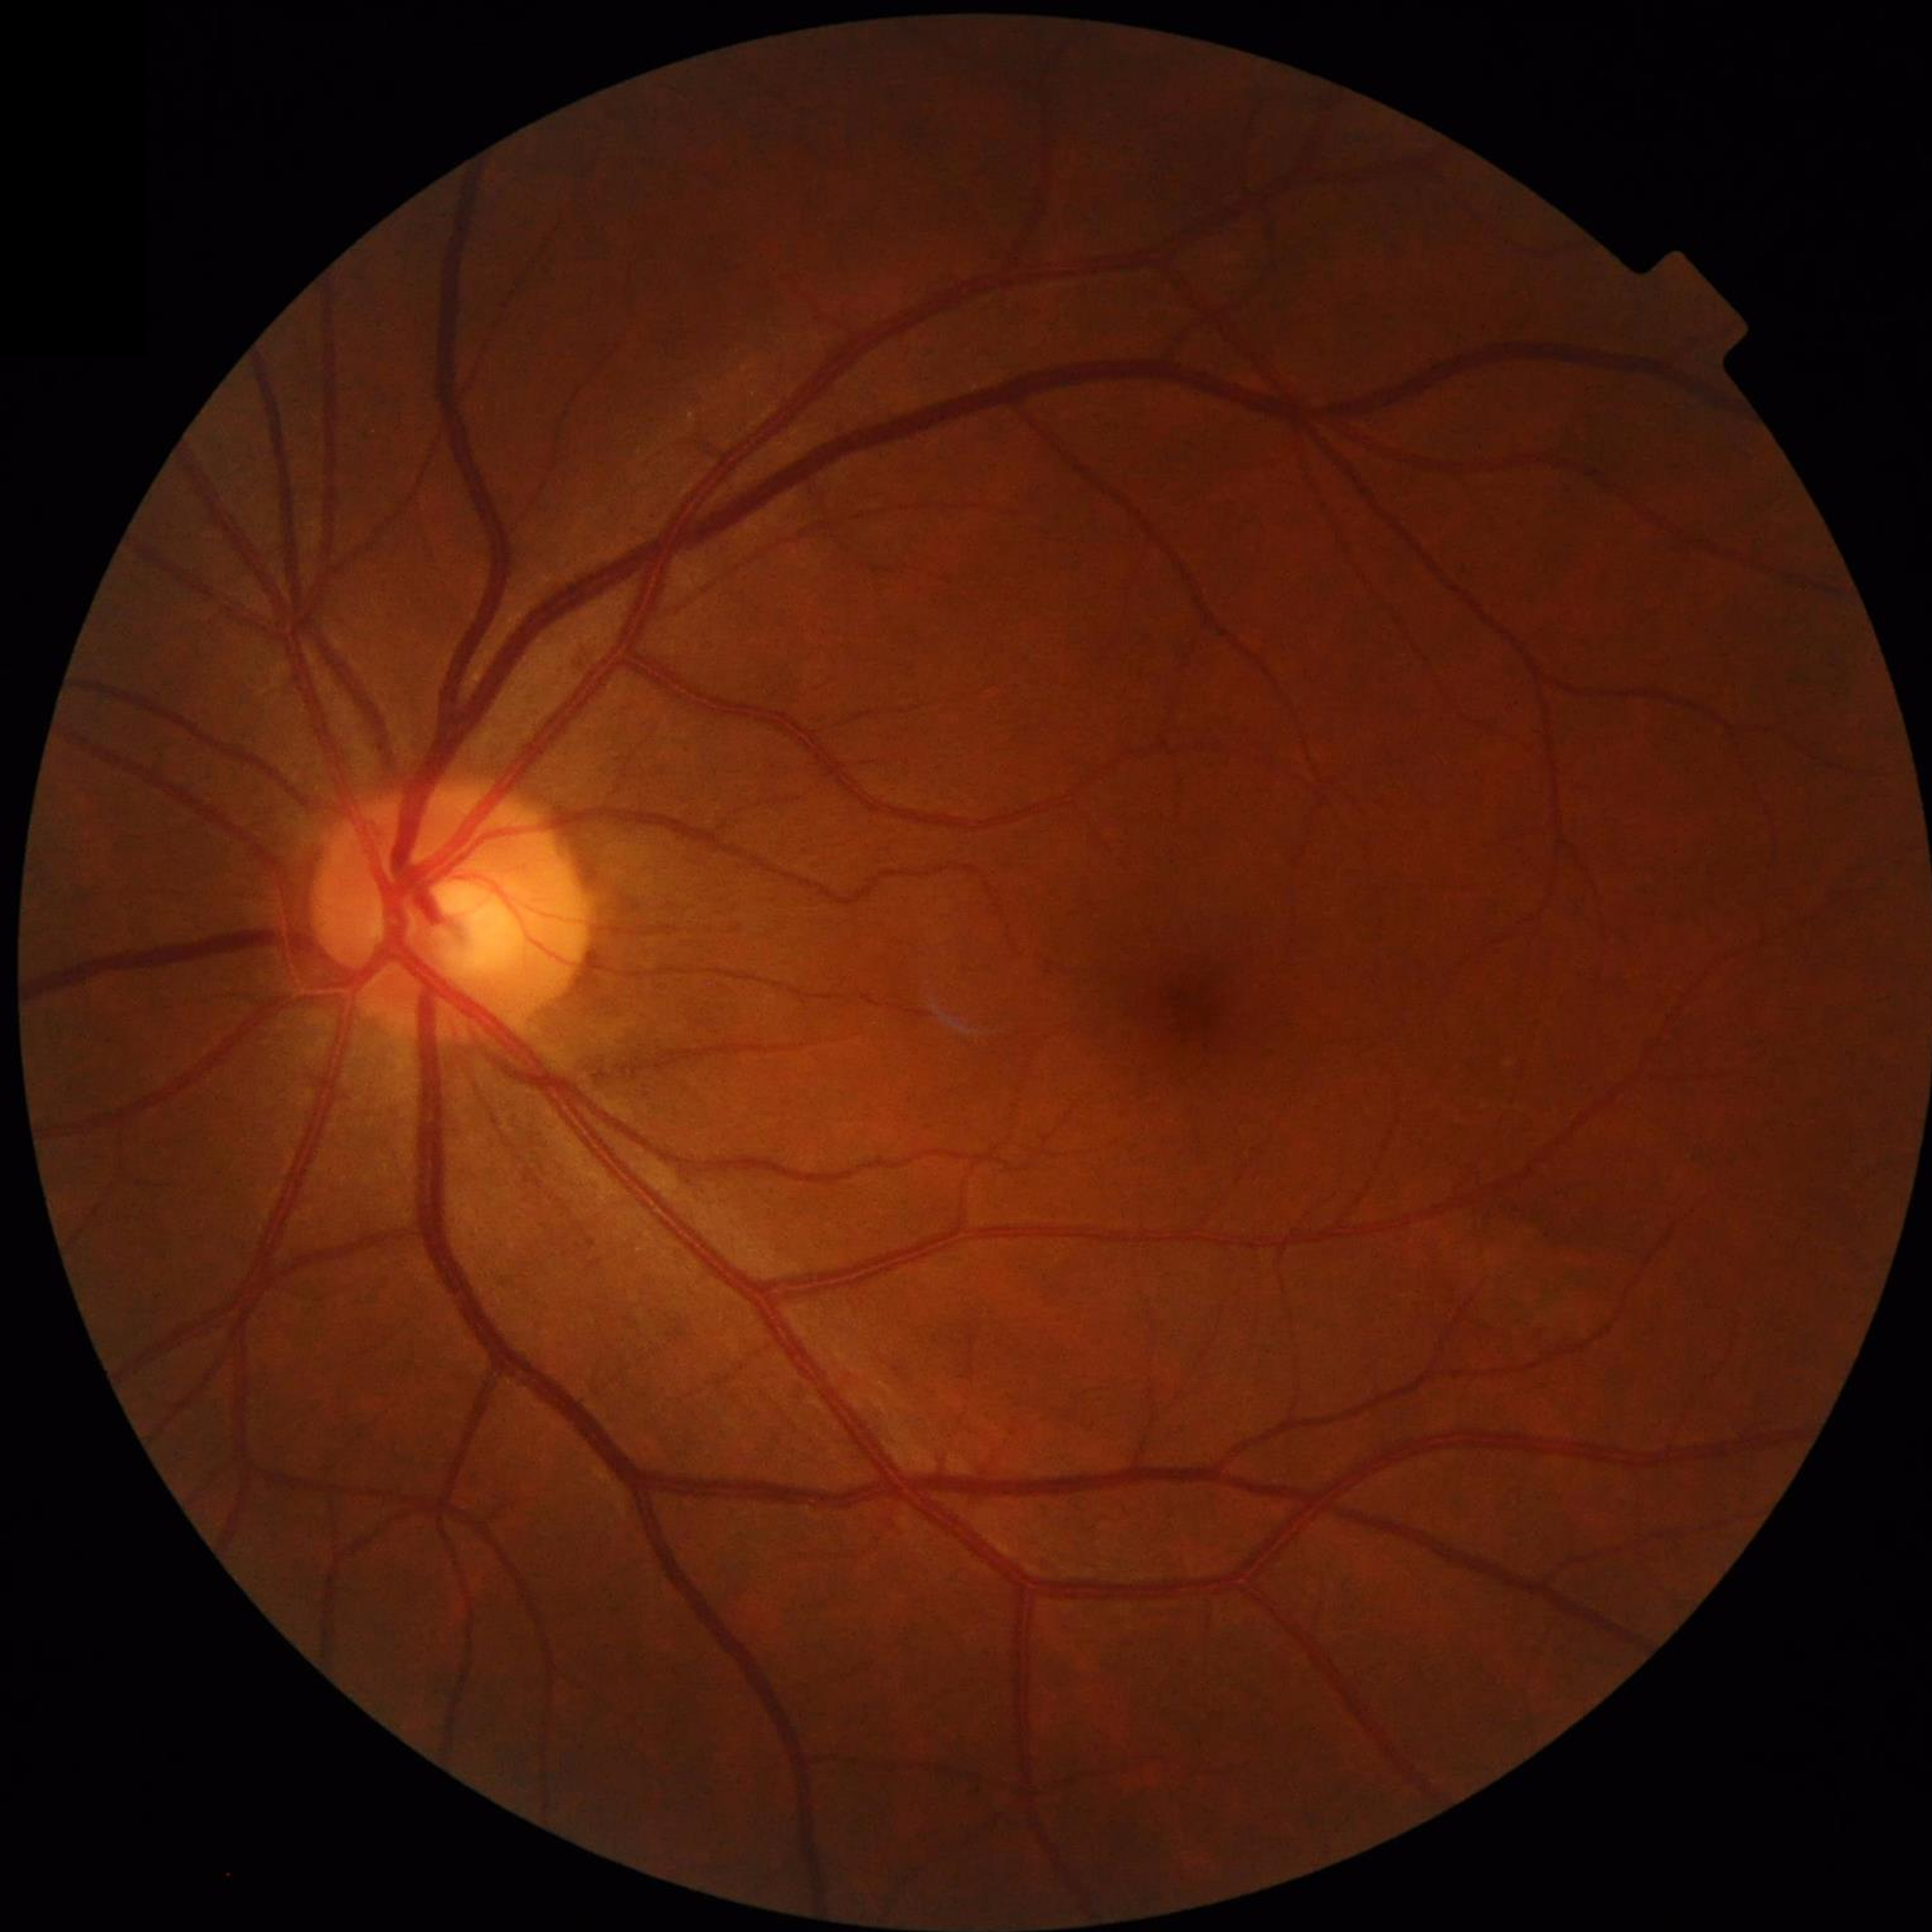

Disease = no AMD, DR, or glaucoma; Image quality = illumination and color satisfactory, contrast adequate, no blur.